Modified Davis grading; posterior pole color fundus photograph; NIDEK AFC-230.
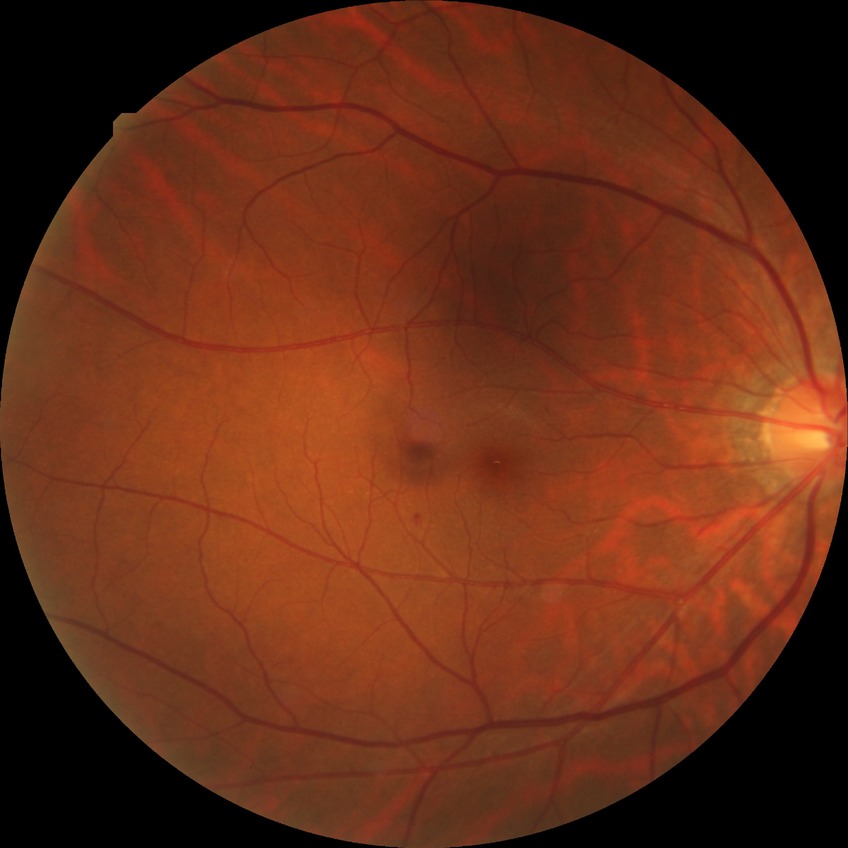

Davis grading: simple diabetic retinopathy.